Camera: Topcon TRC-50DX. Central posterior field. 2228 x 1652 pixels. Retinal fundus photograph. FOV: 50 degrees. Dilated-pupil acquisition: 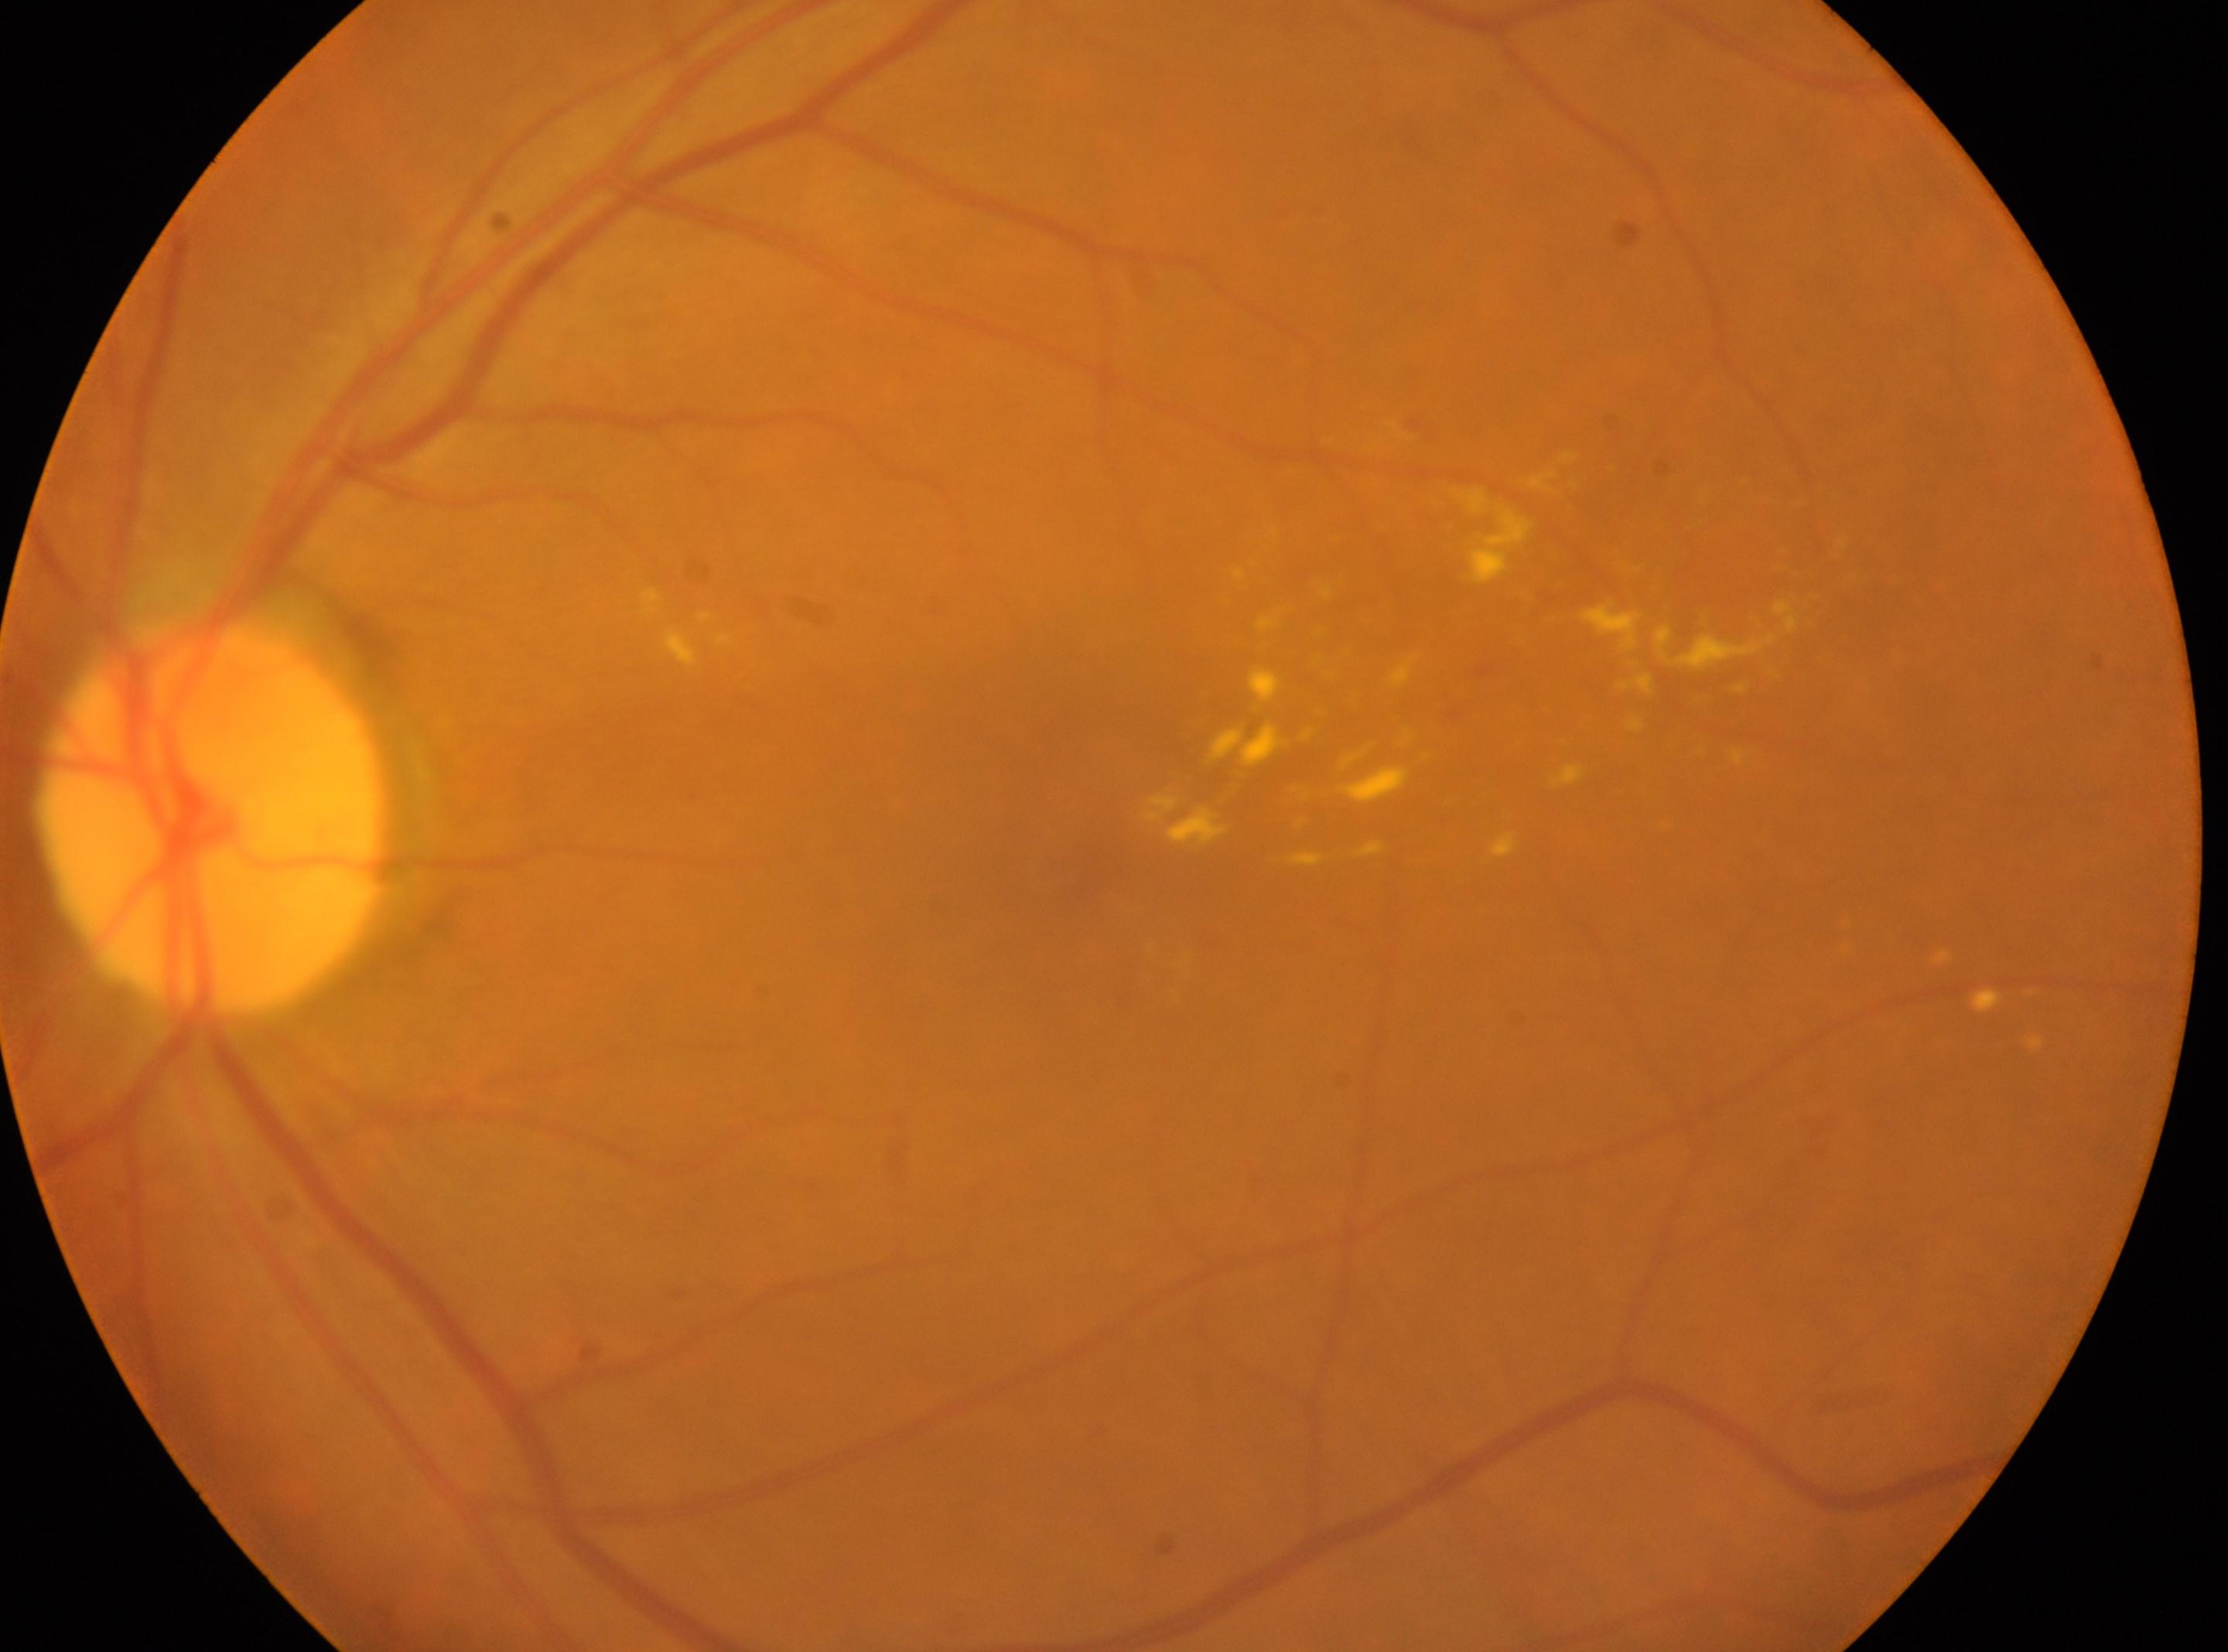 Q: Locate the fovea.
A: (x: 1052, y: 868)
Q: What is the laterality?
A: left
Q: What is the DR grade?
A: grade 2
Q: Locate the optic disc.
A: (x: 211, y: 815)